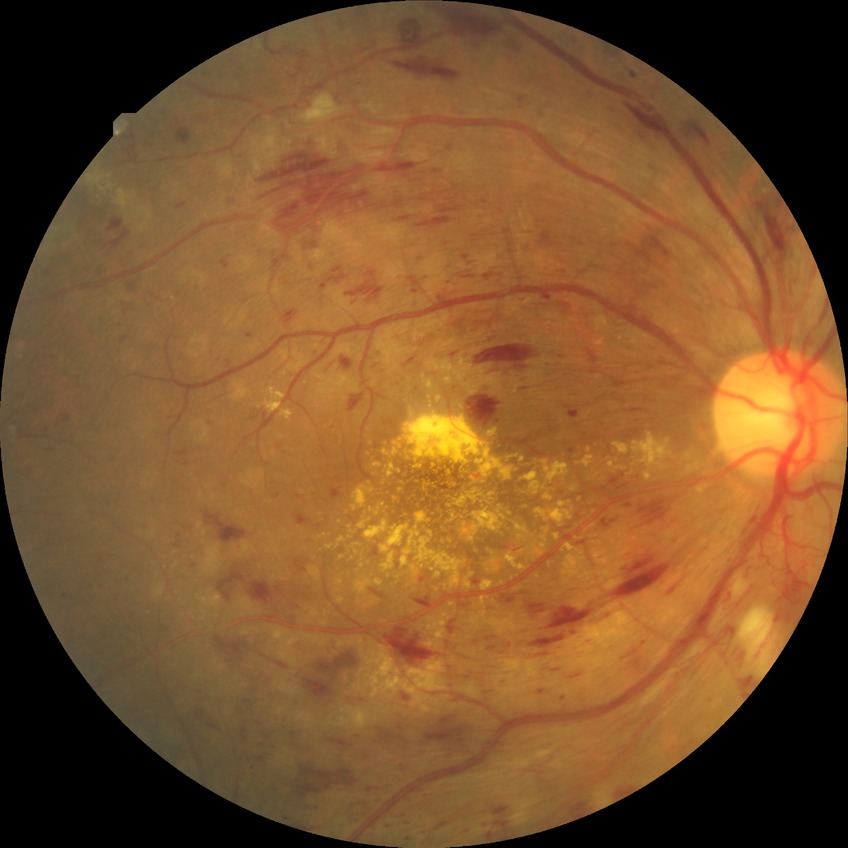 Diabetic retinopathy grade is proliferative diabetic retinopathy.